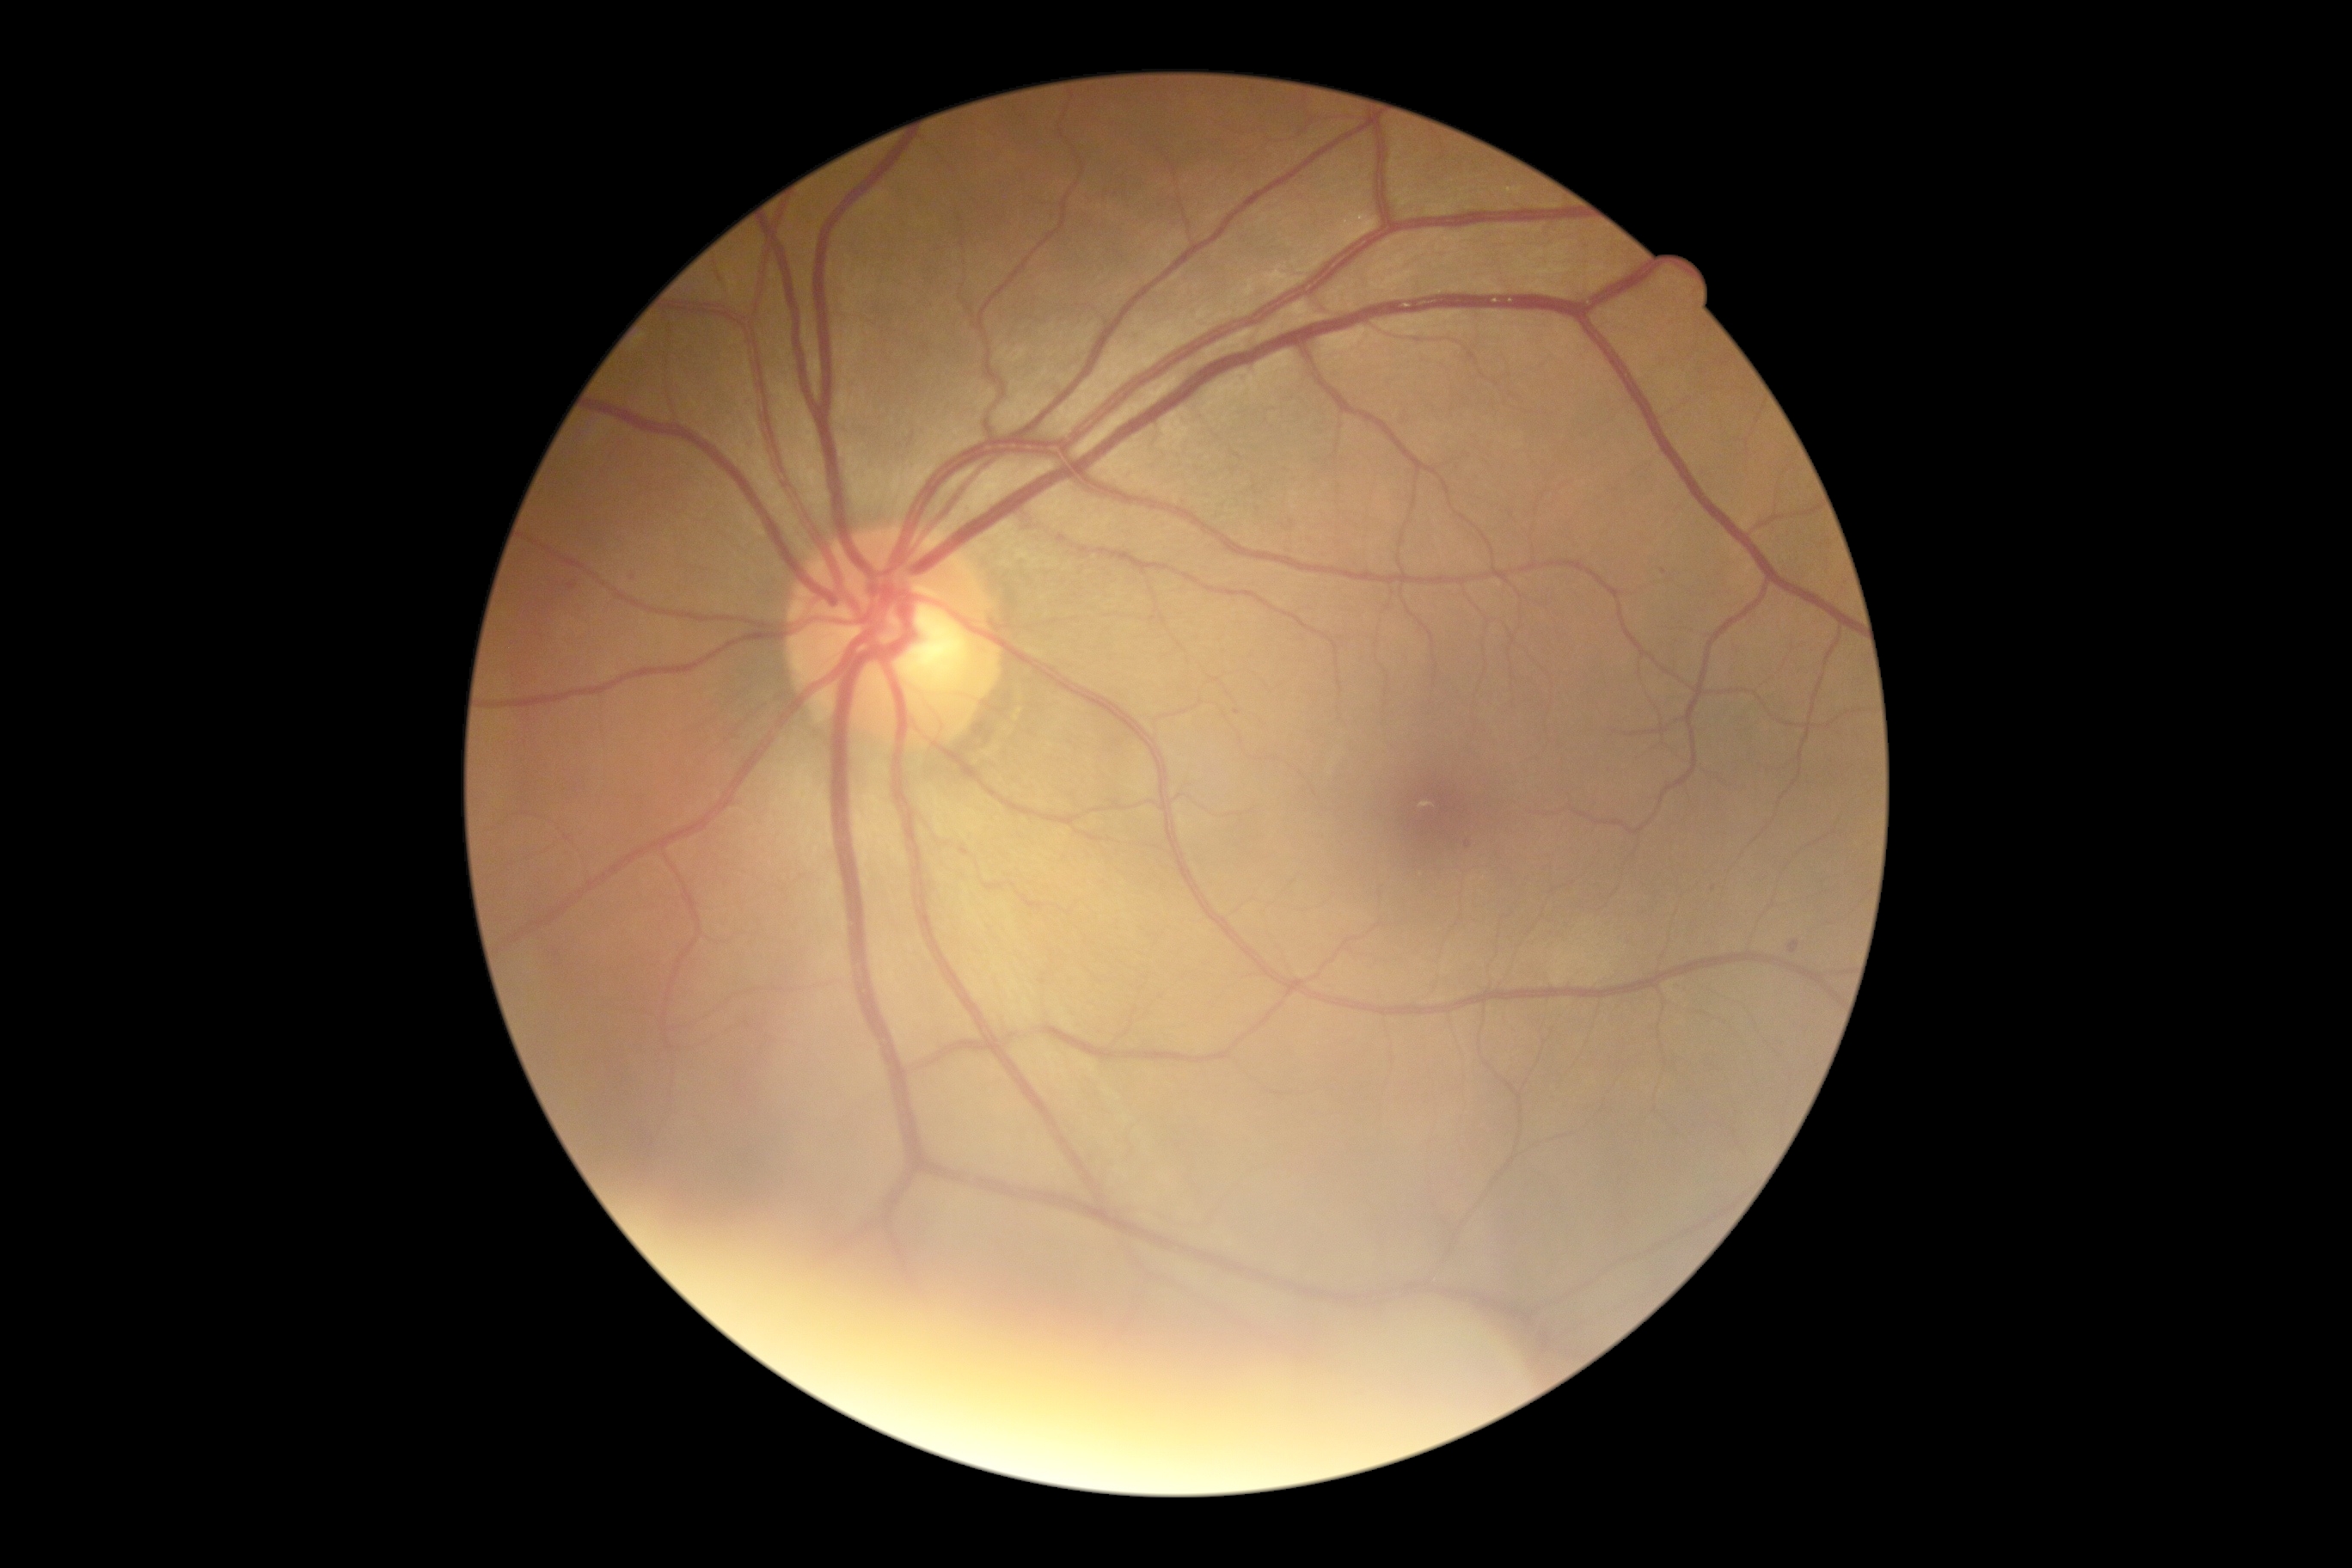
Retinopathy grade: 1 (mild NPDR).